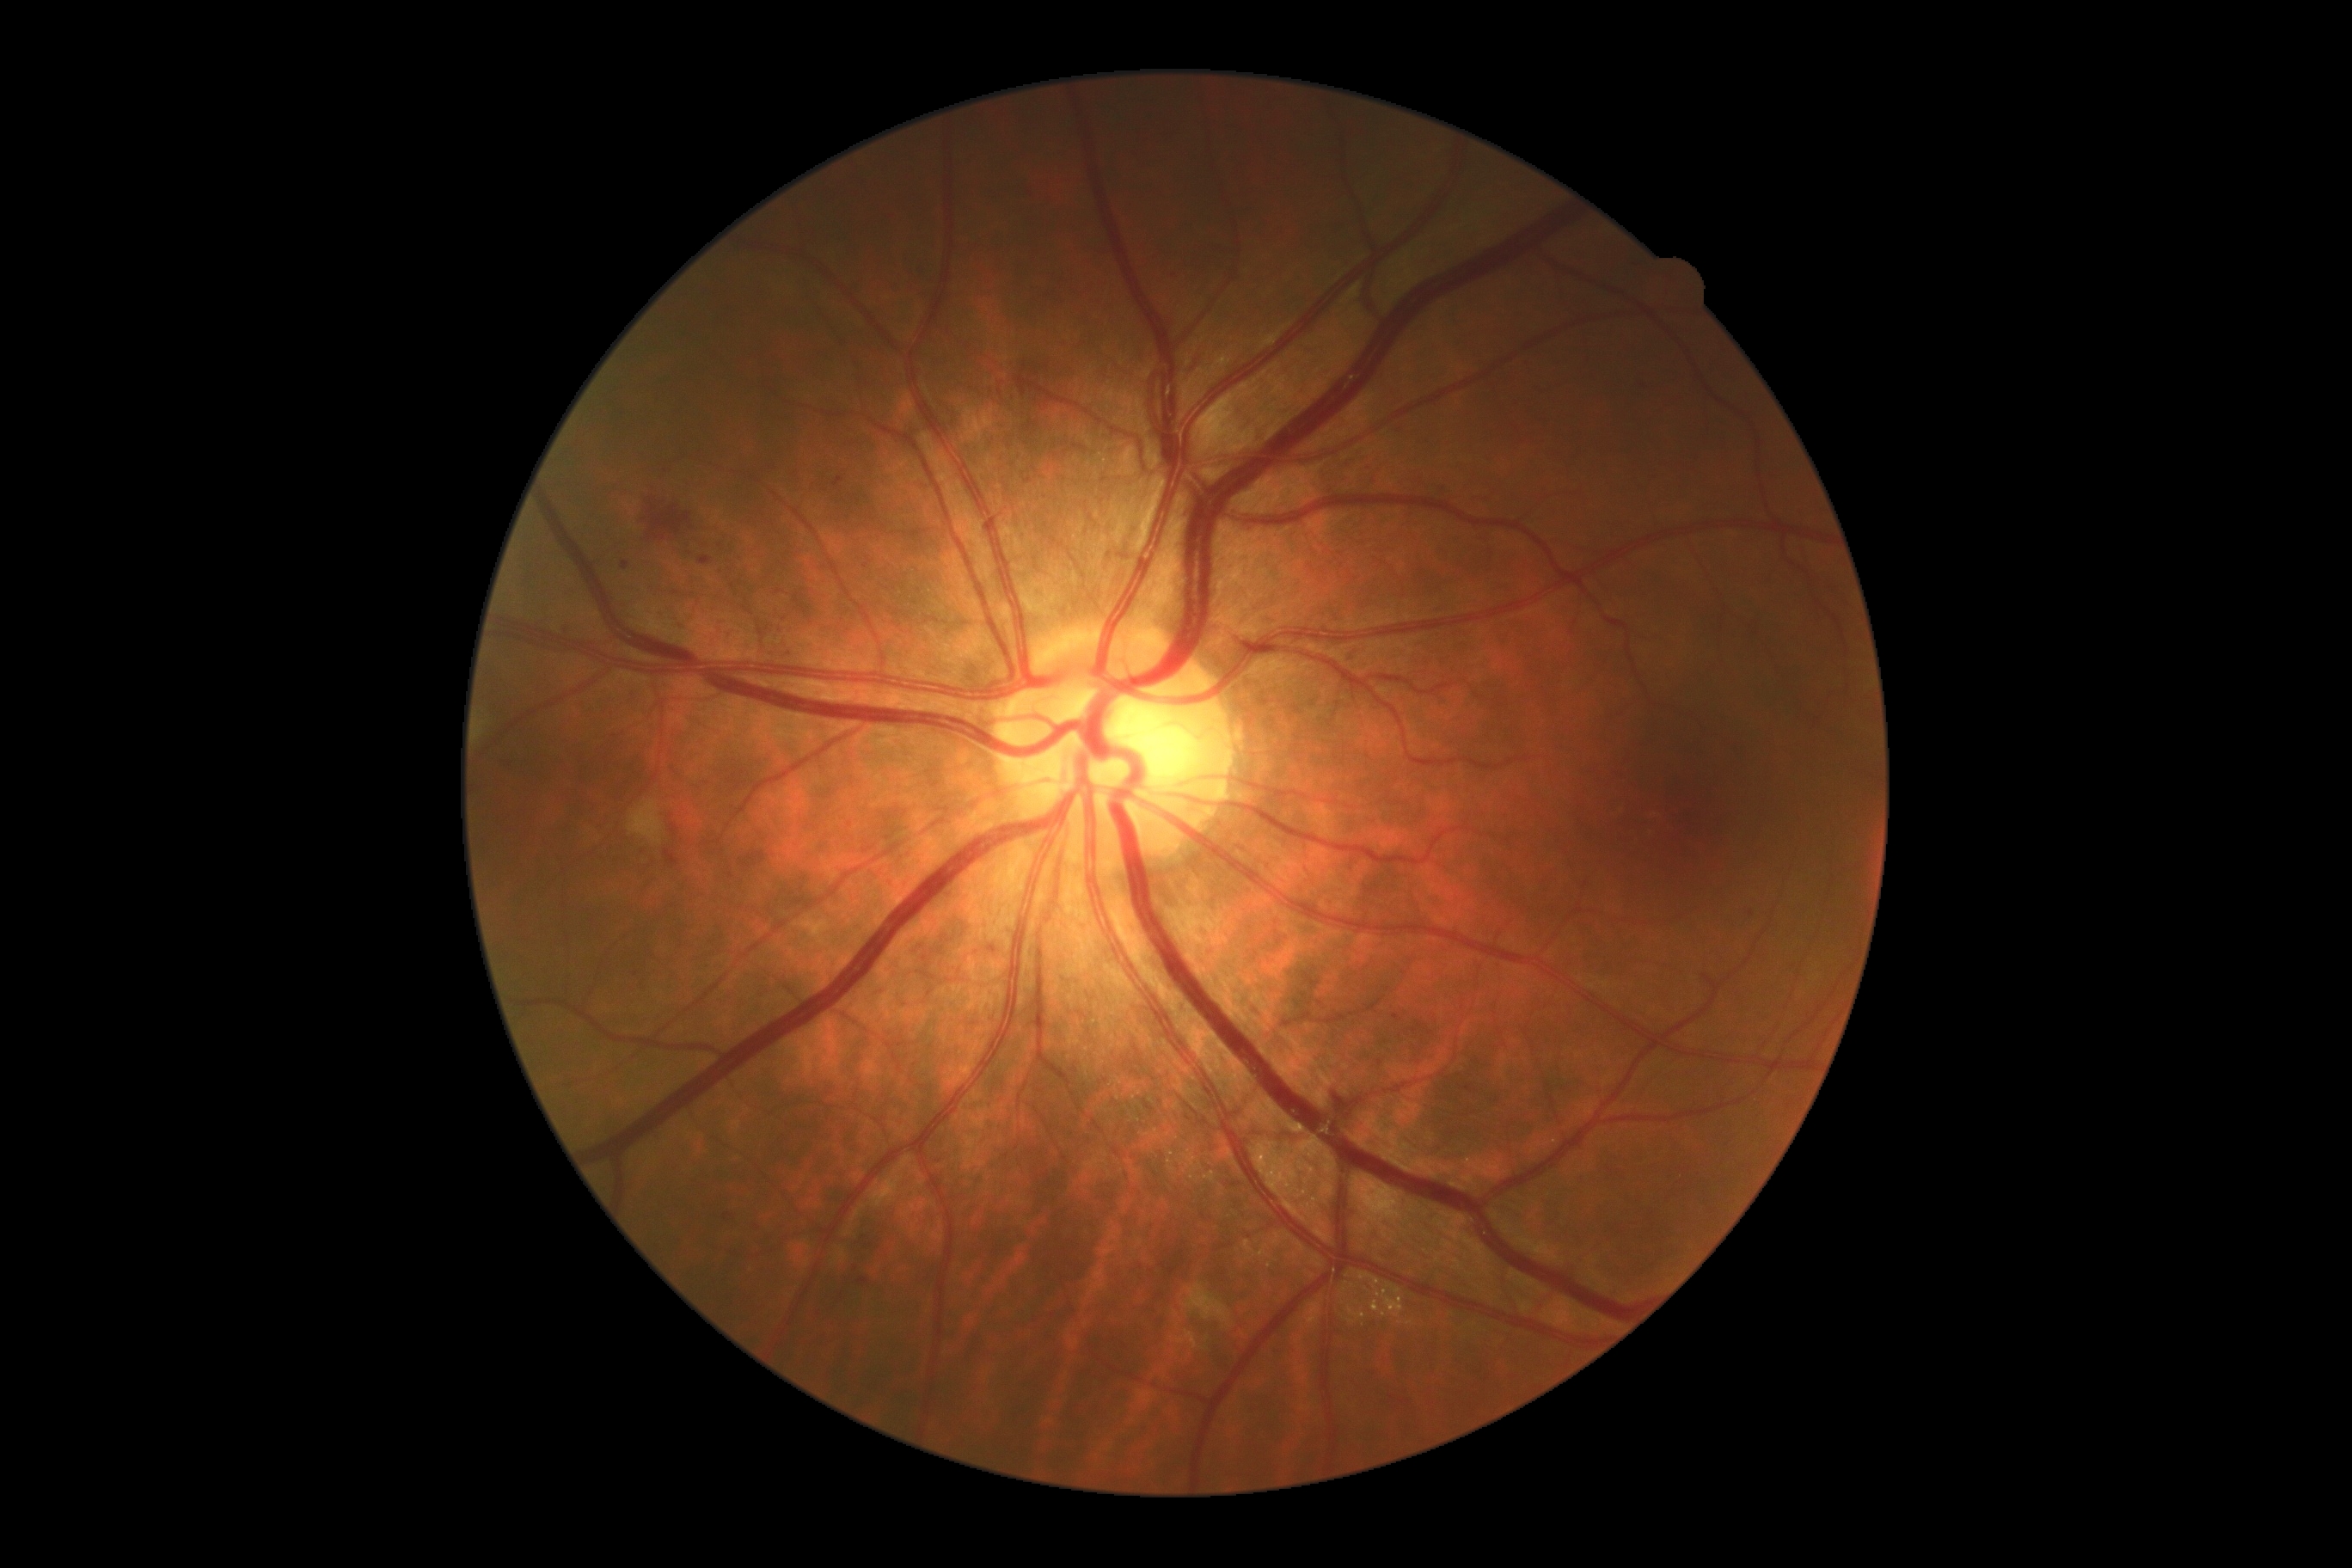
Diabetic retinopathy: 2/4.